Nonmydriatic — 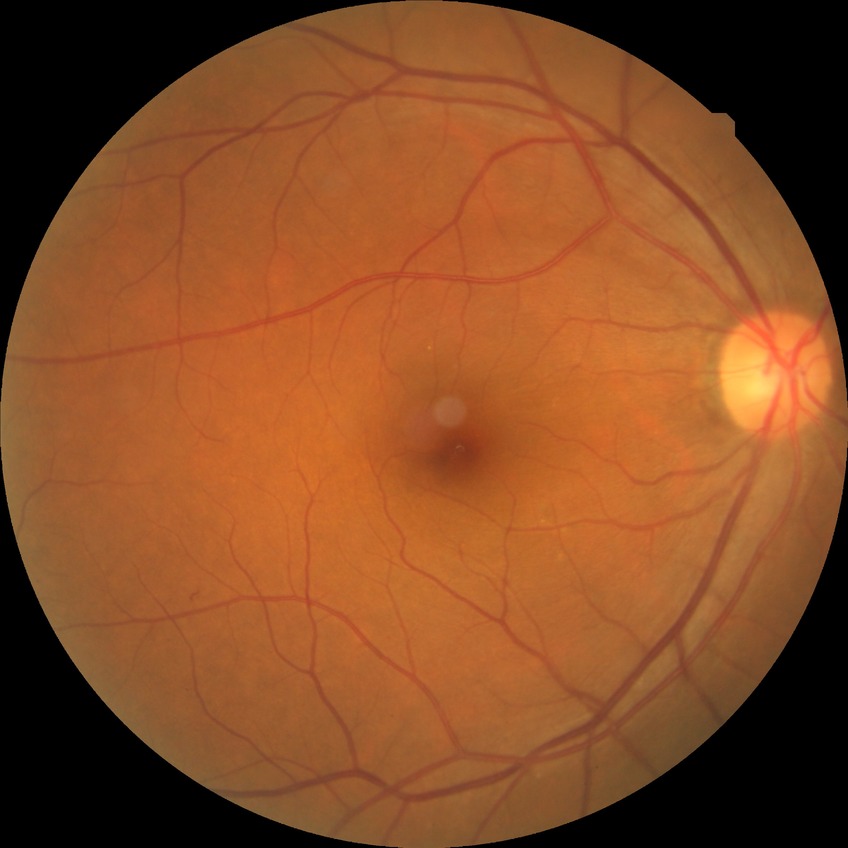 diabetic retinopathy (DR) = simple diabetic retinopathy (SDR)